2352 by 1568 pixels
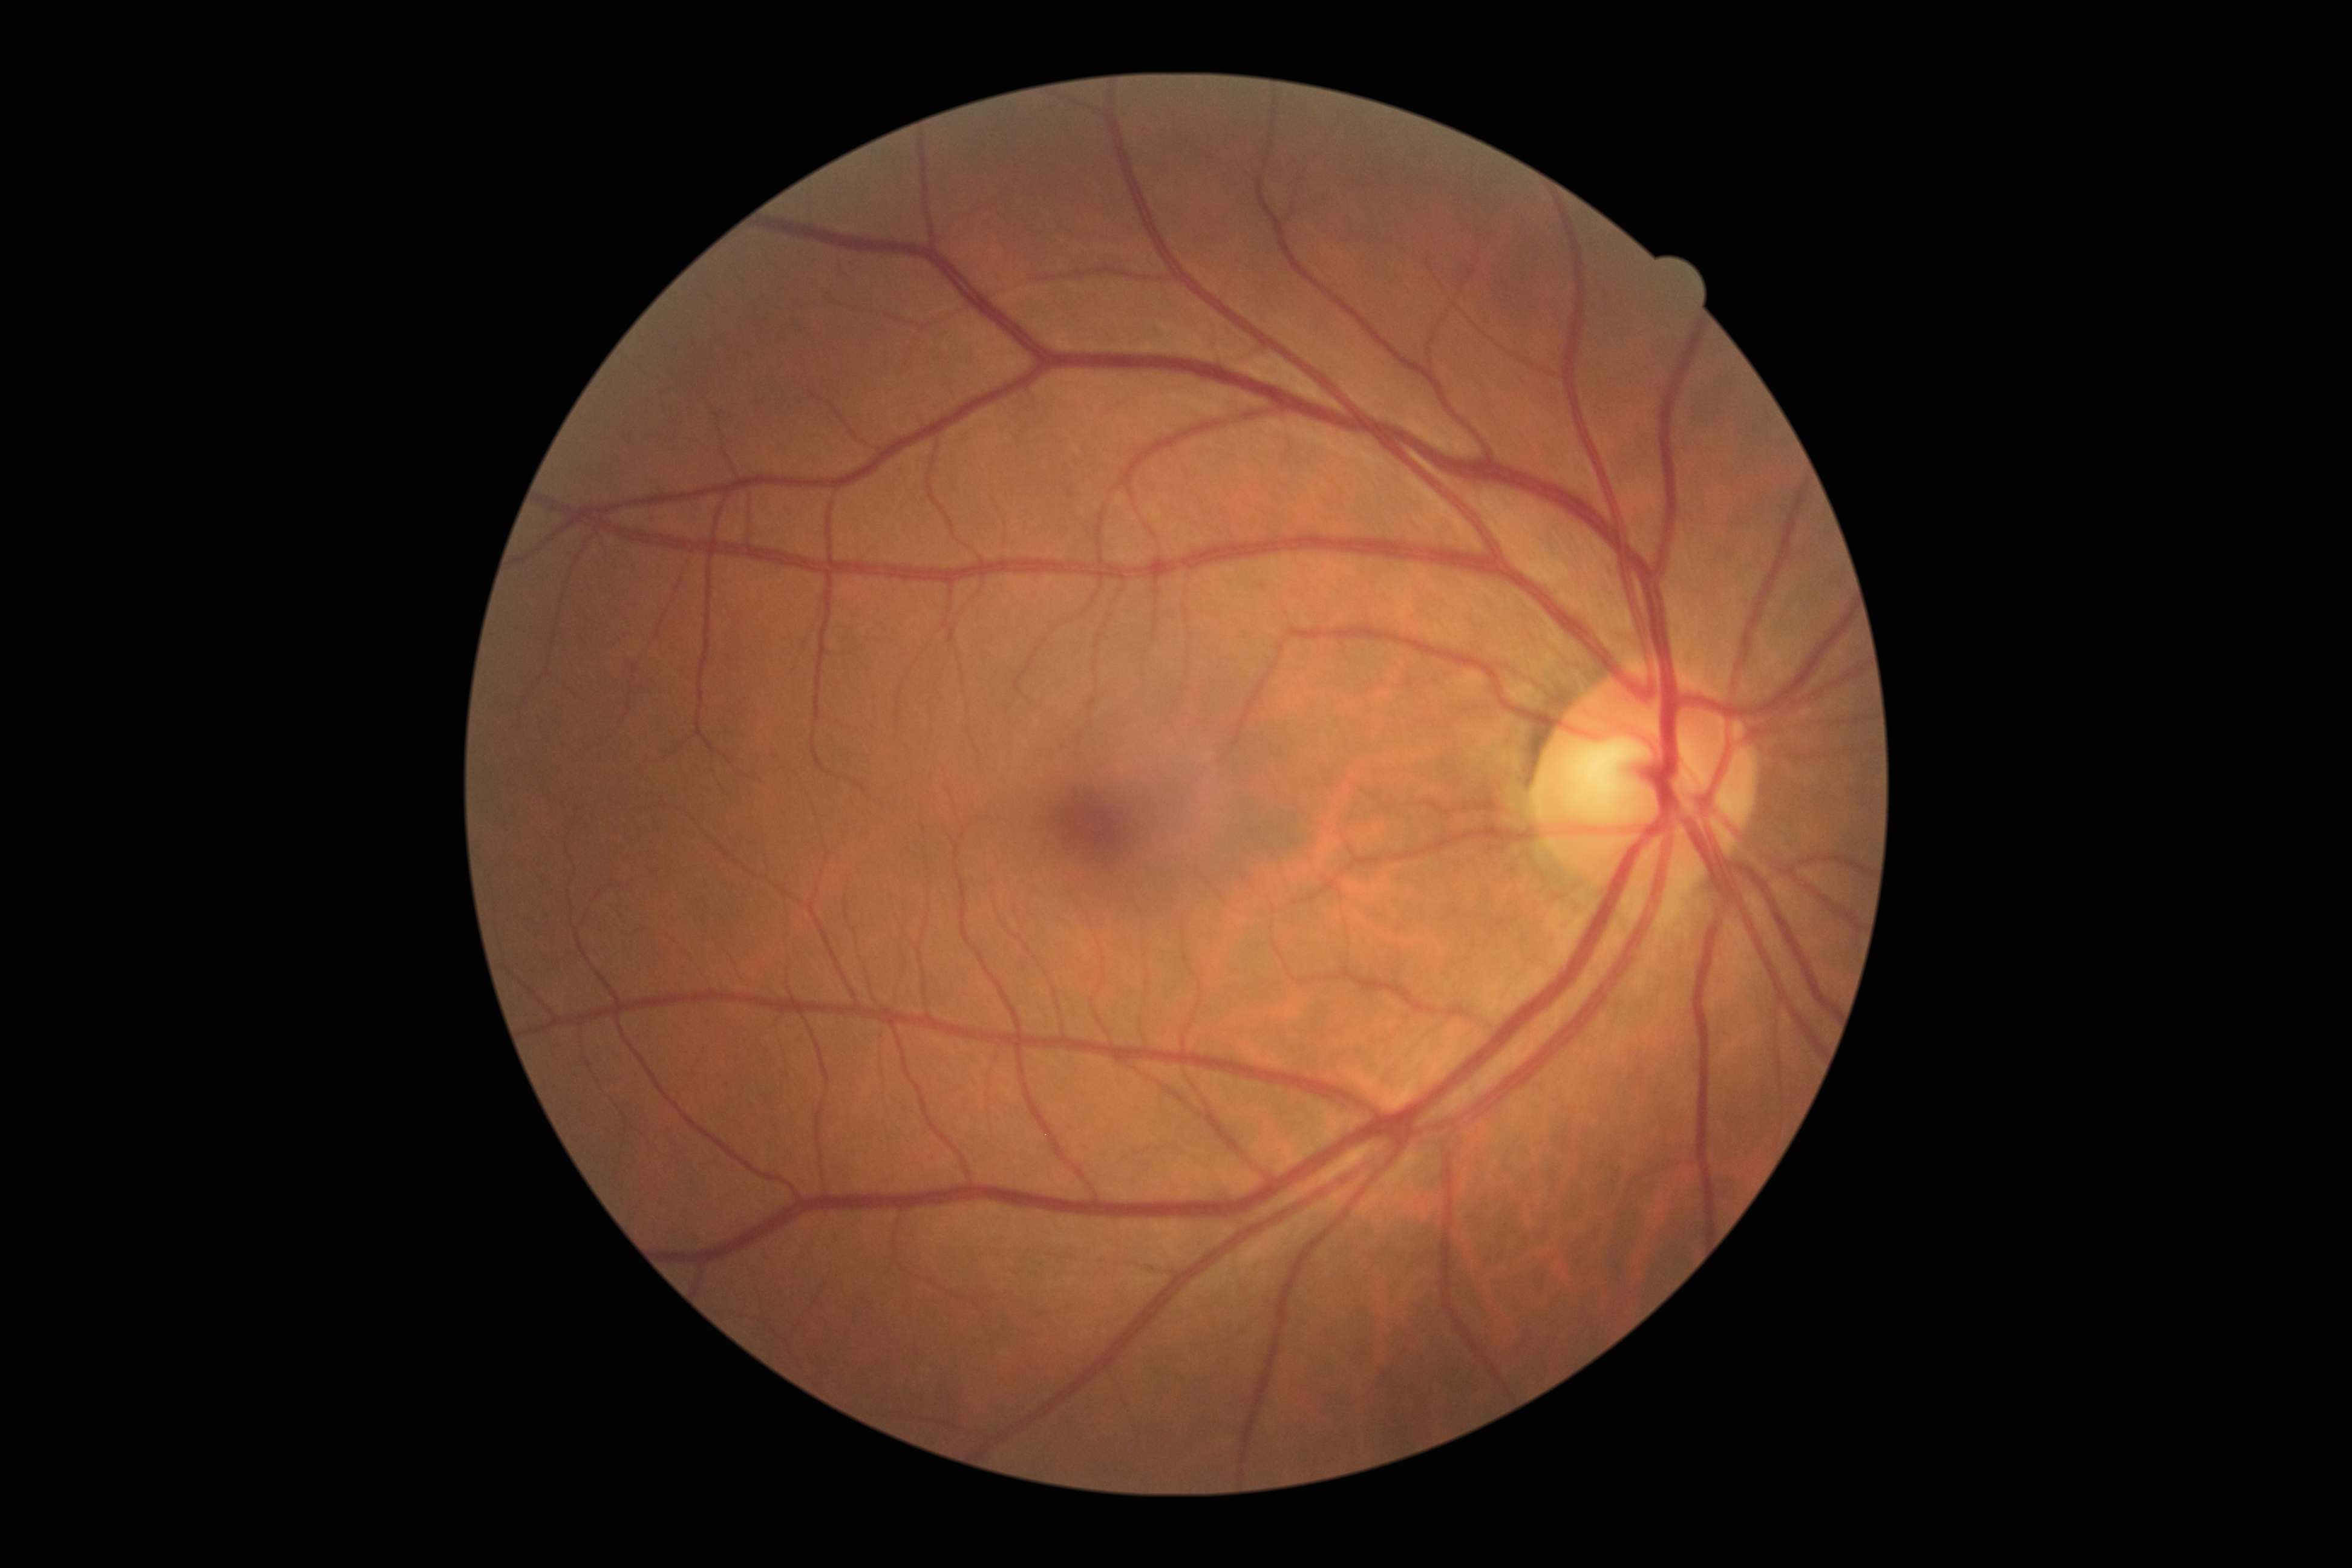 DR stage: grade 0. No apparent diabetic retinopathy.